Acquired with a NIDEK AFC-230 · modified Davis classification · without pupil dilation: 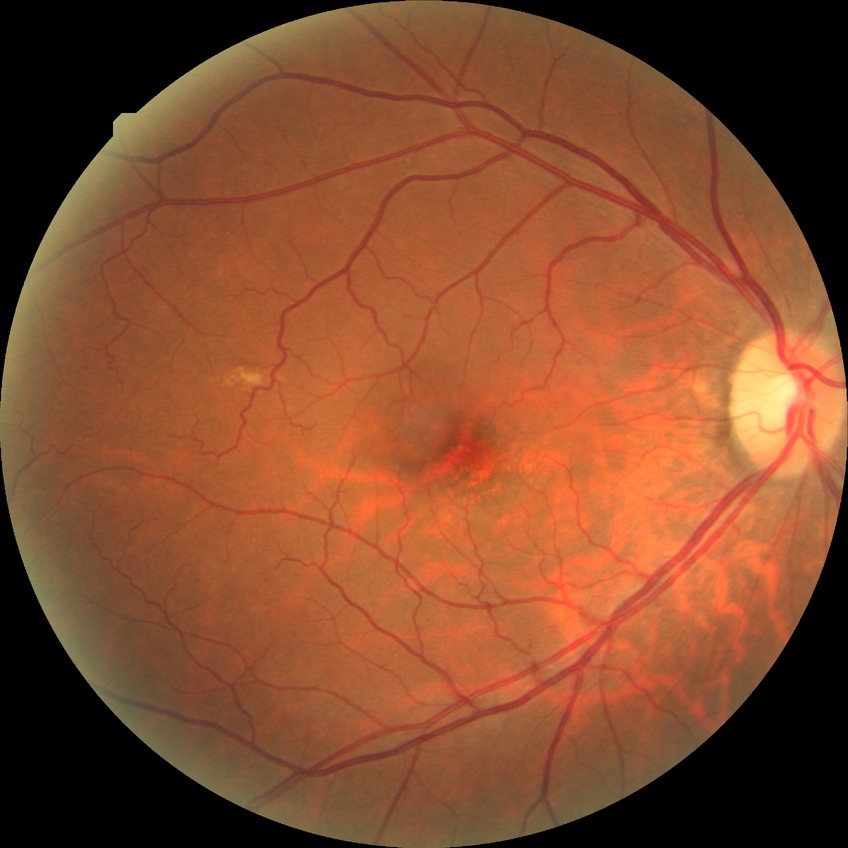 Diabetic retinopathy (DR) is NDR (no diabetic retinopathy).